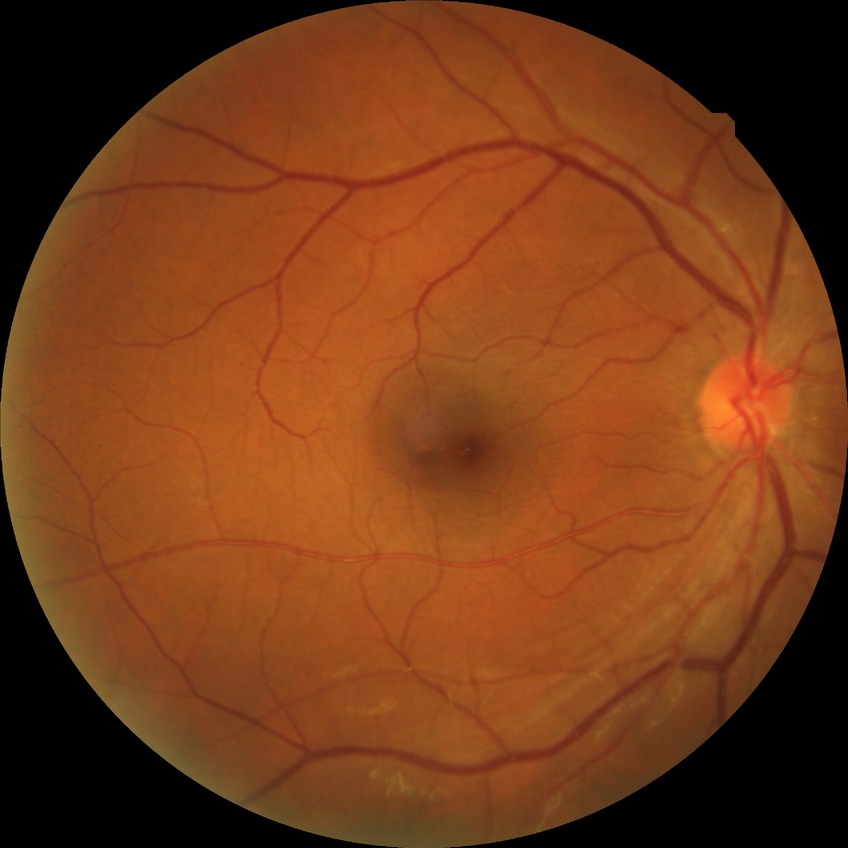
Diabetic retinopathy (DR) is NDR (no diabetic retinopathy).